Color fundus photograph; pupil-dilated.
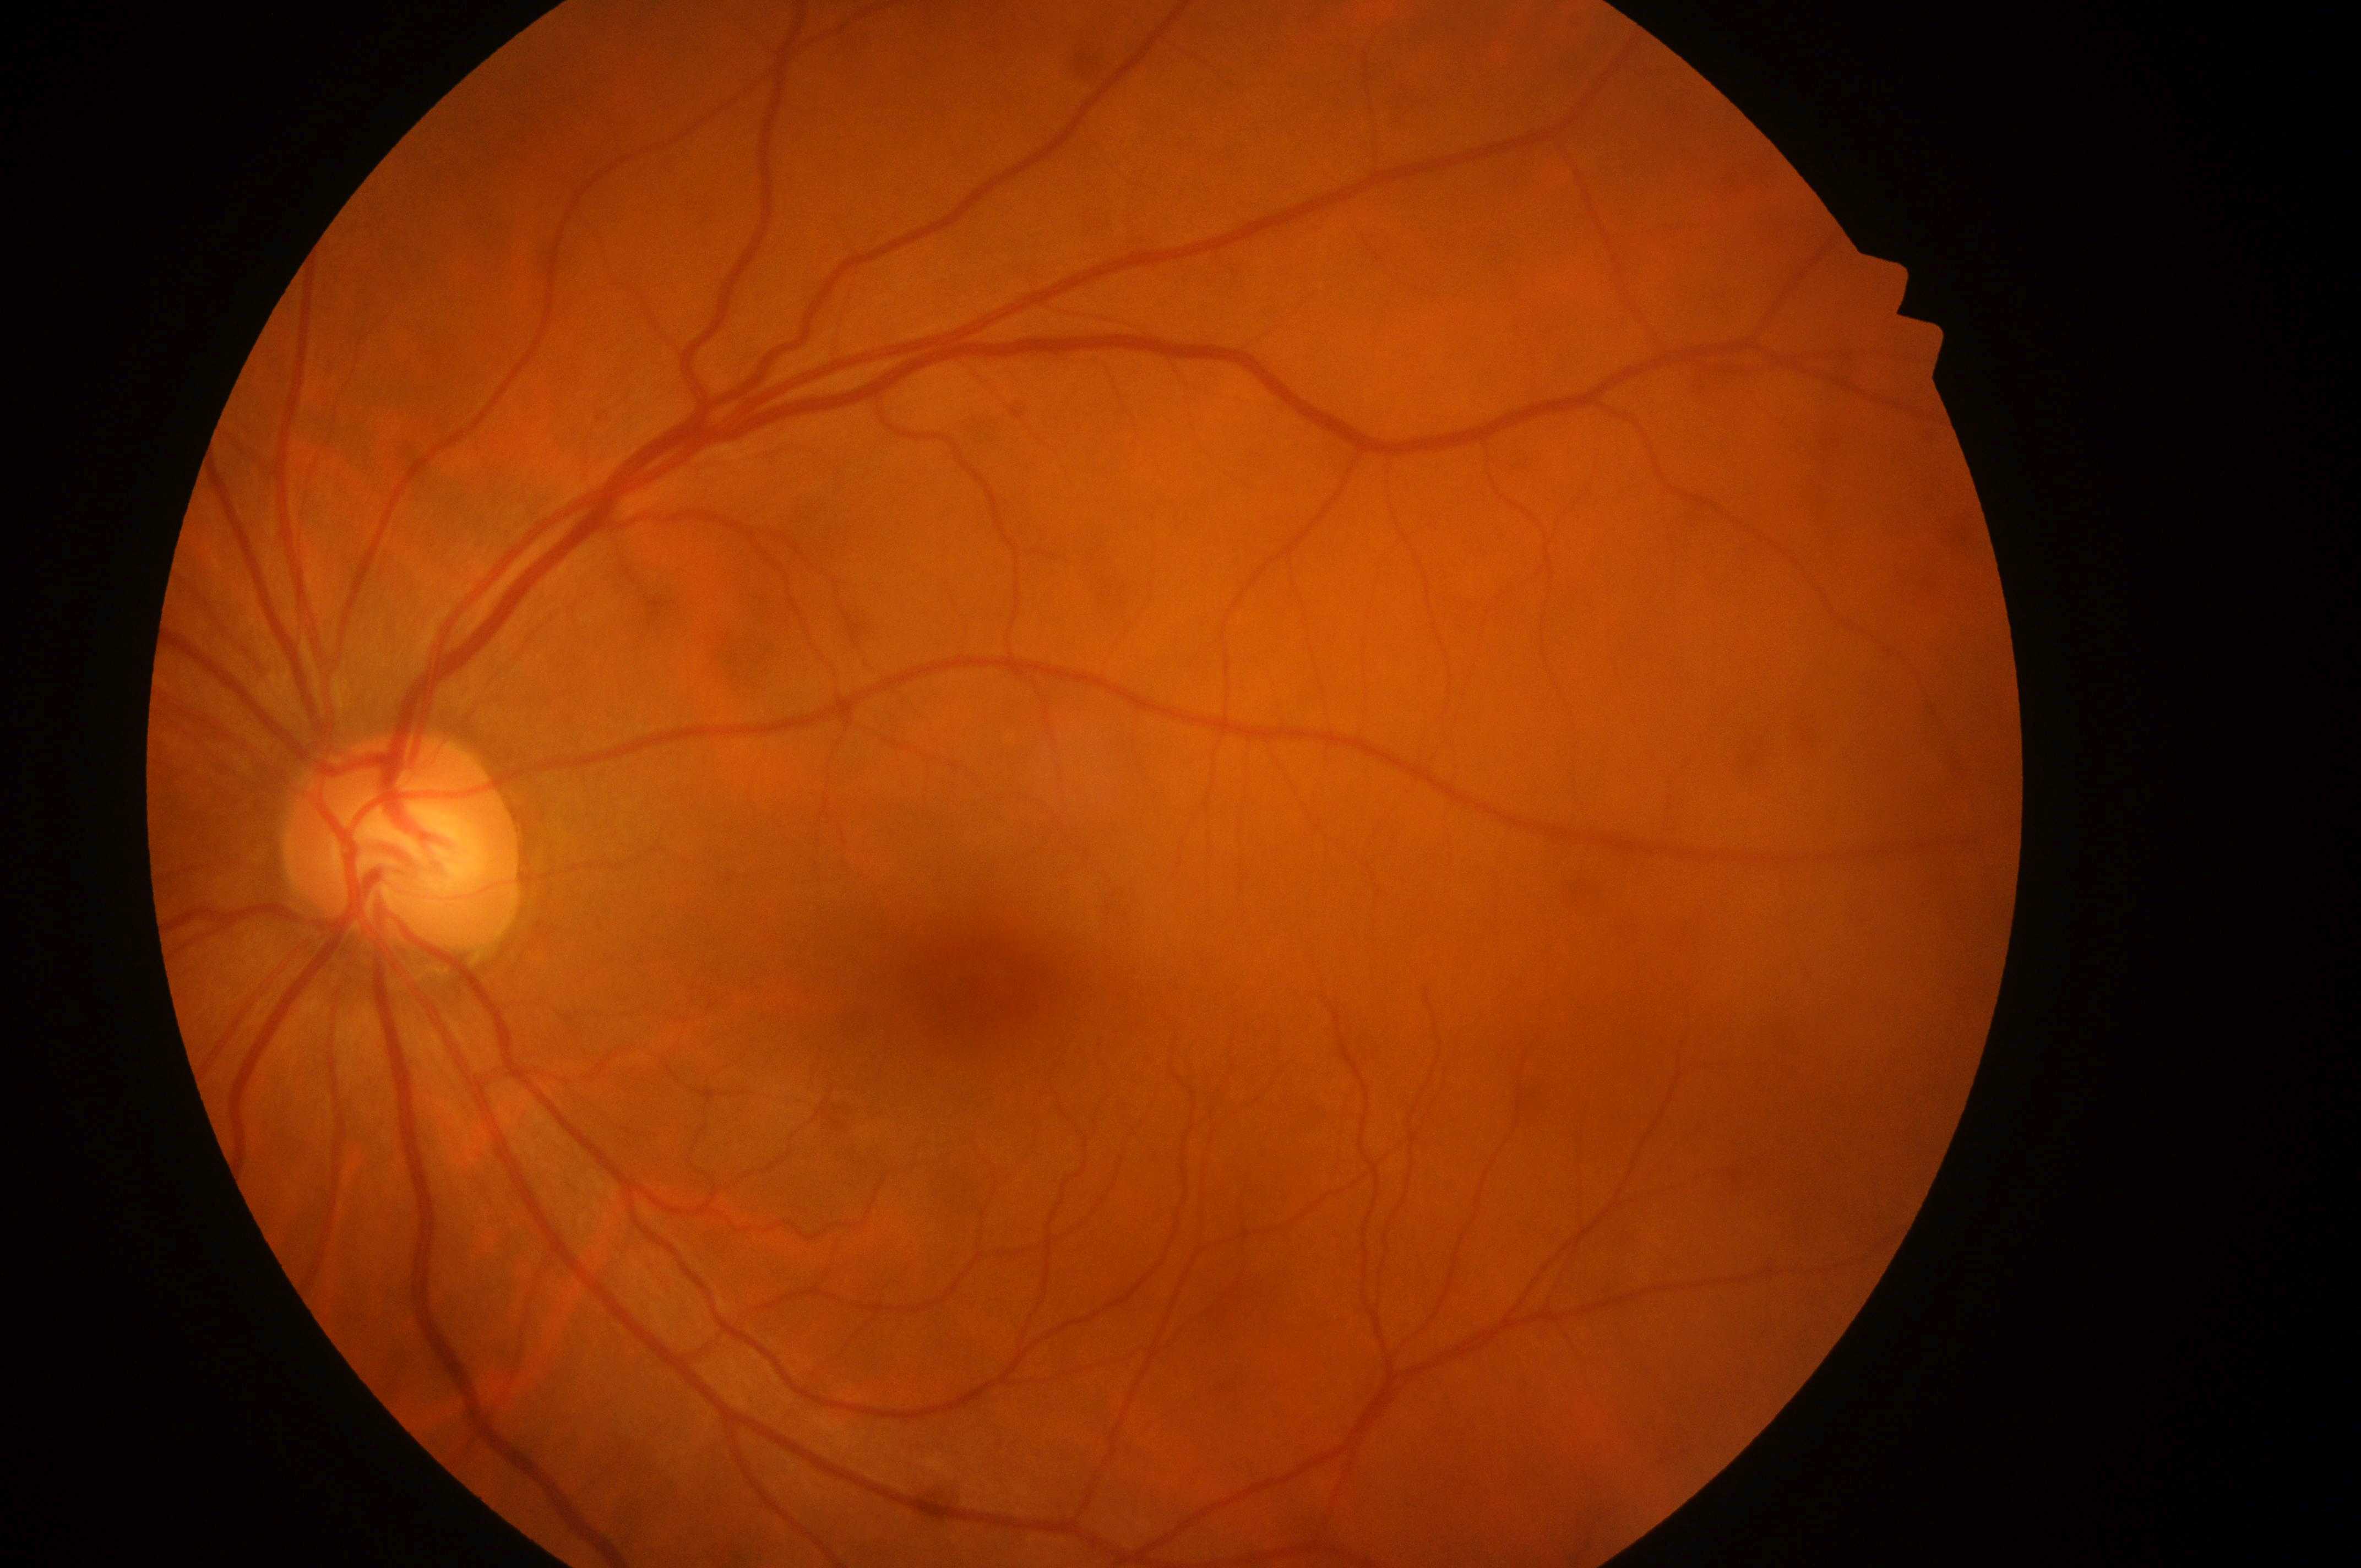

DR severity: grade 0.
Eye: OS.
DME risk: 0/2.
No apparent diabetic retinopathy or macular edema.
Fovea center: (984,986).
Optic disk: (400,864).